2048x1536px — 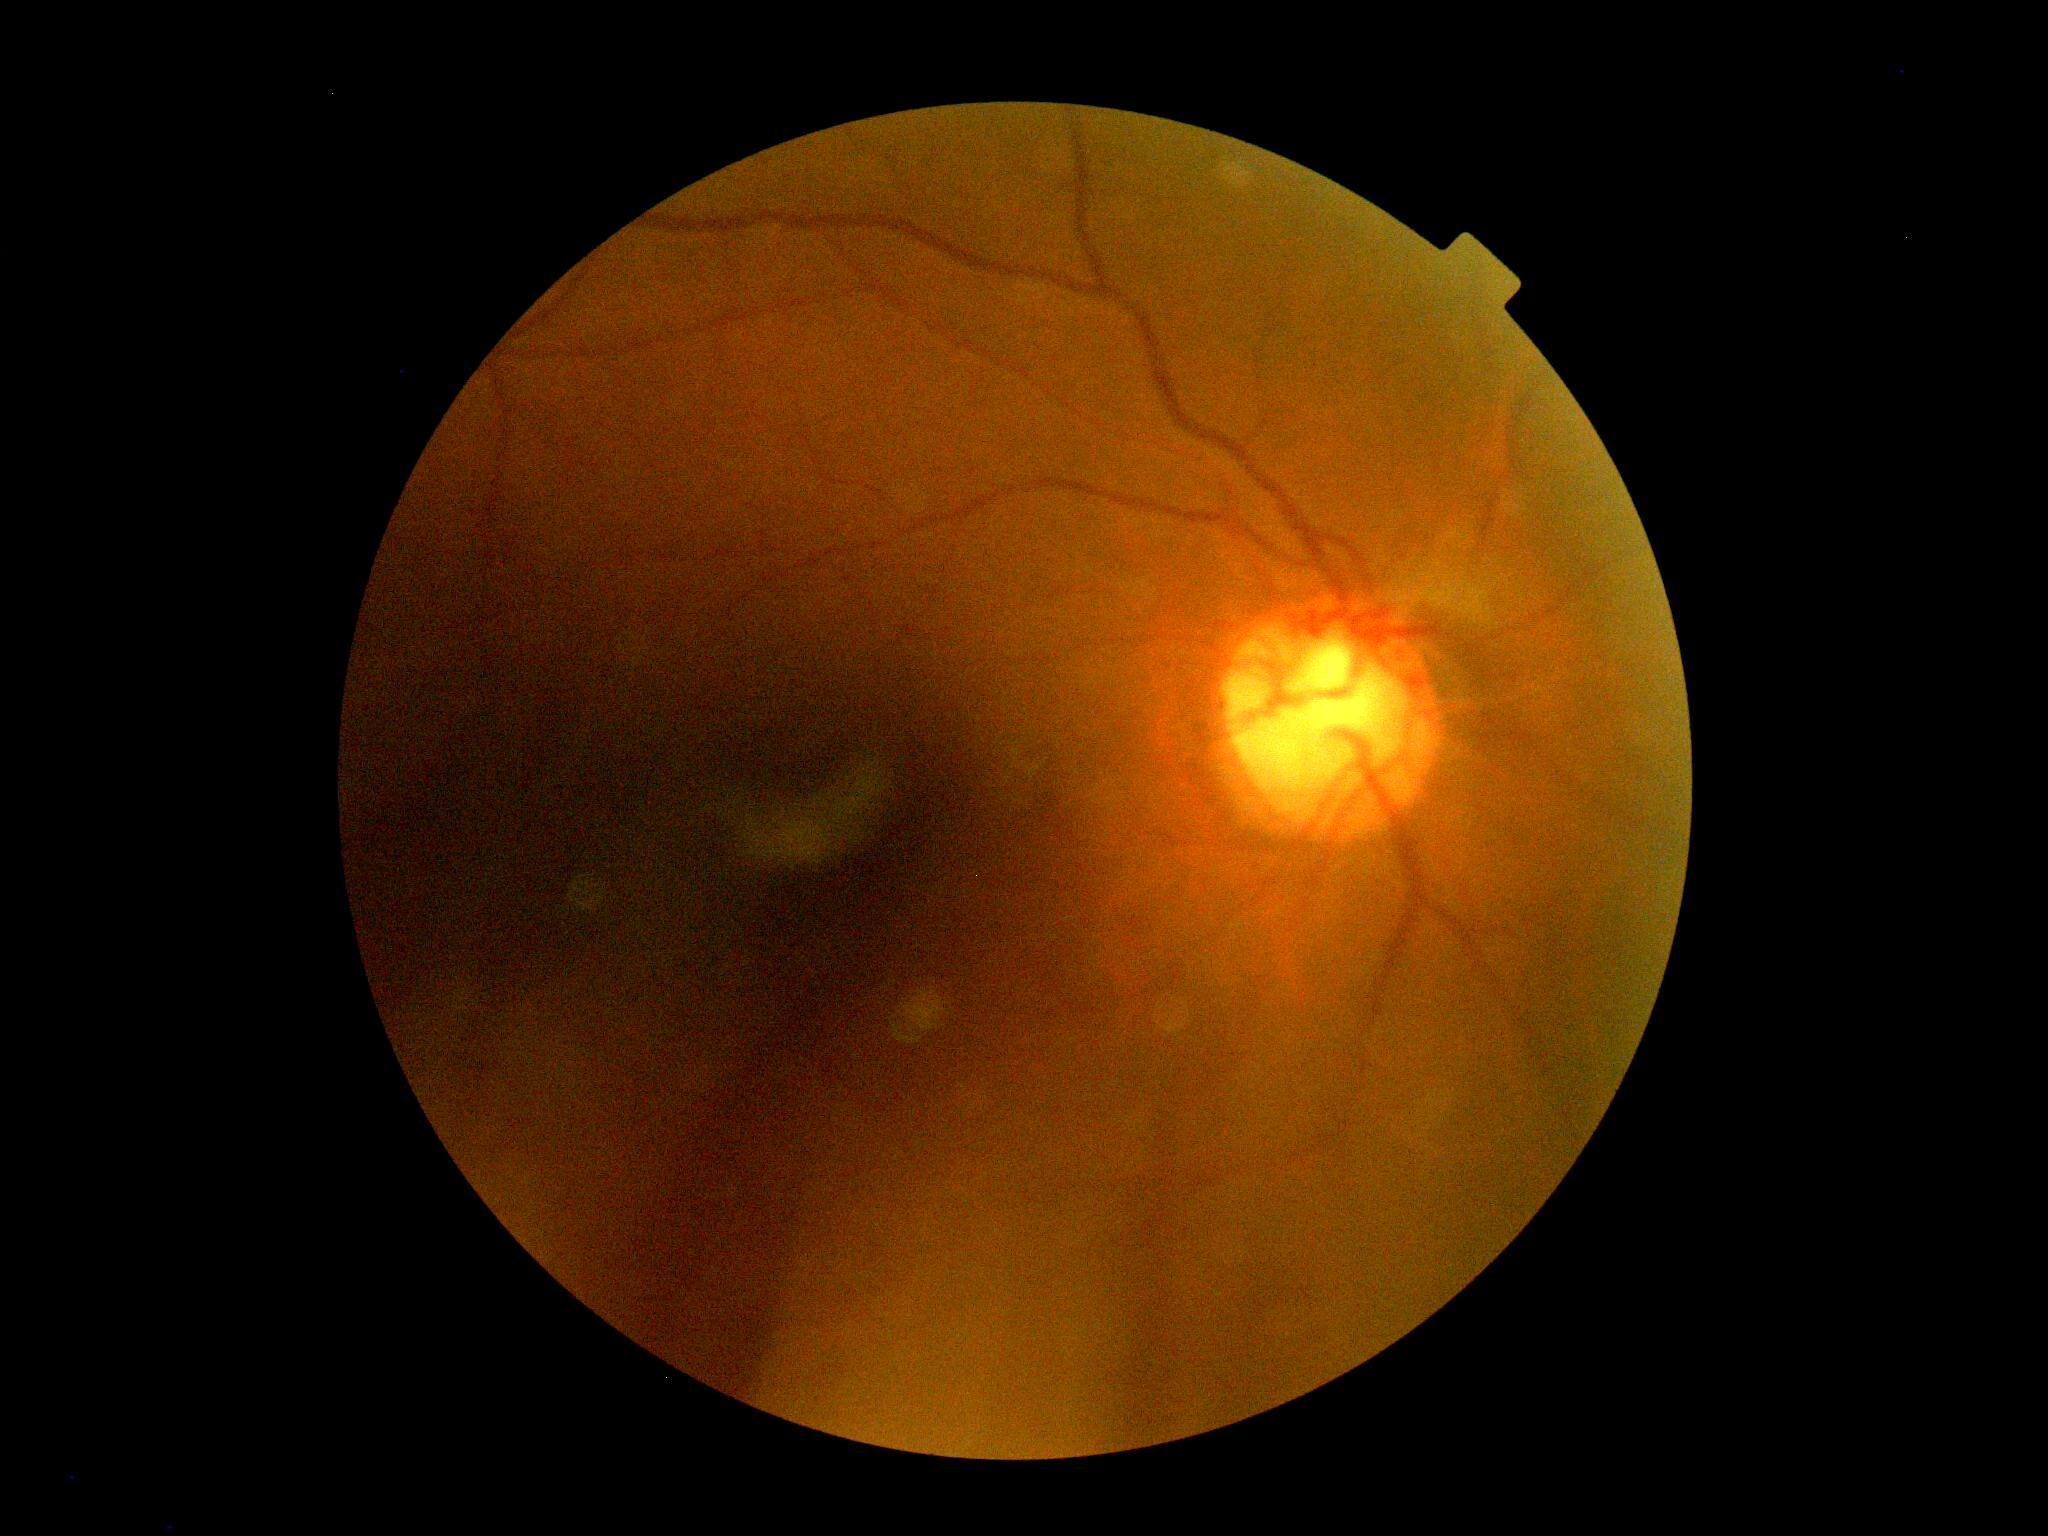

No diabetic retinal disease findings. DR grade: no apparent diabetic retinopathy (0).